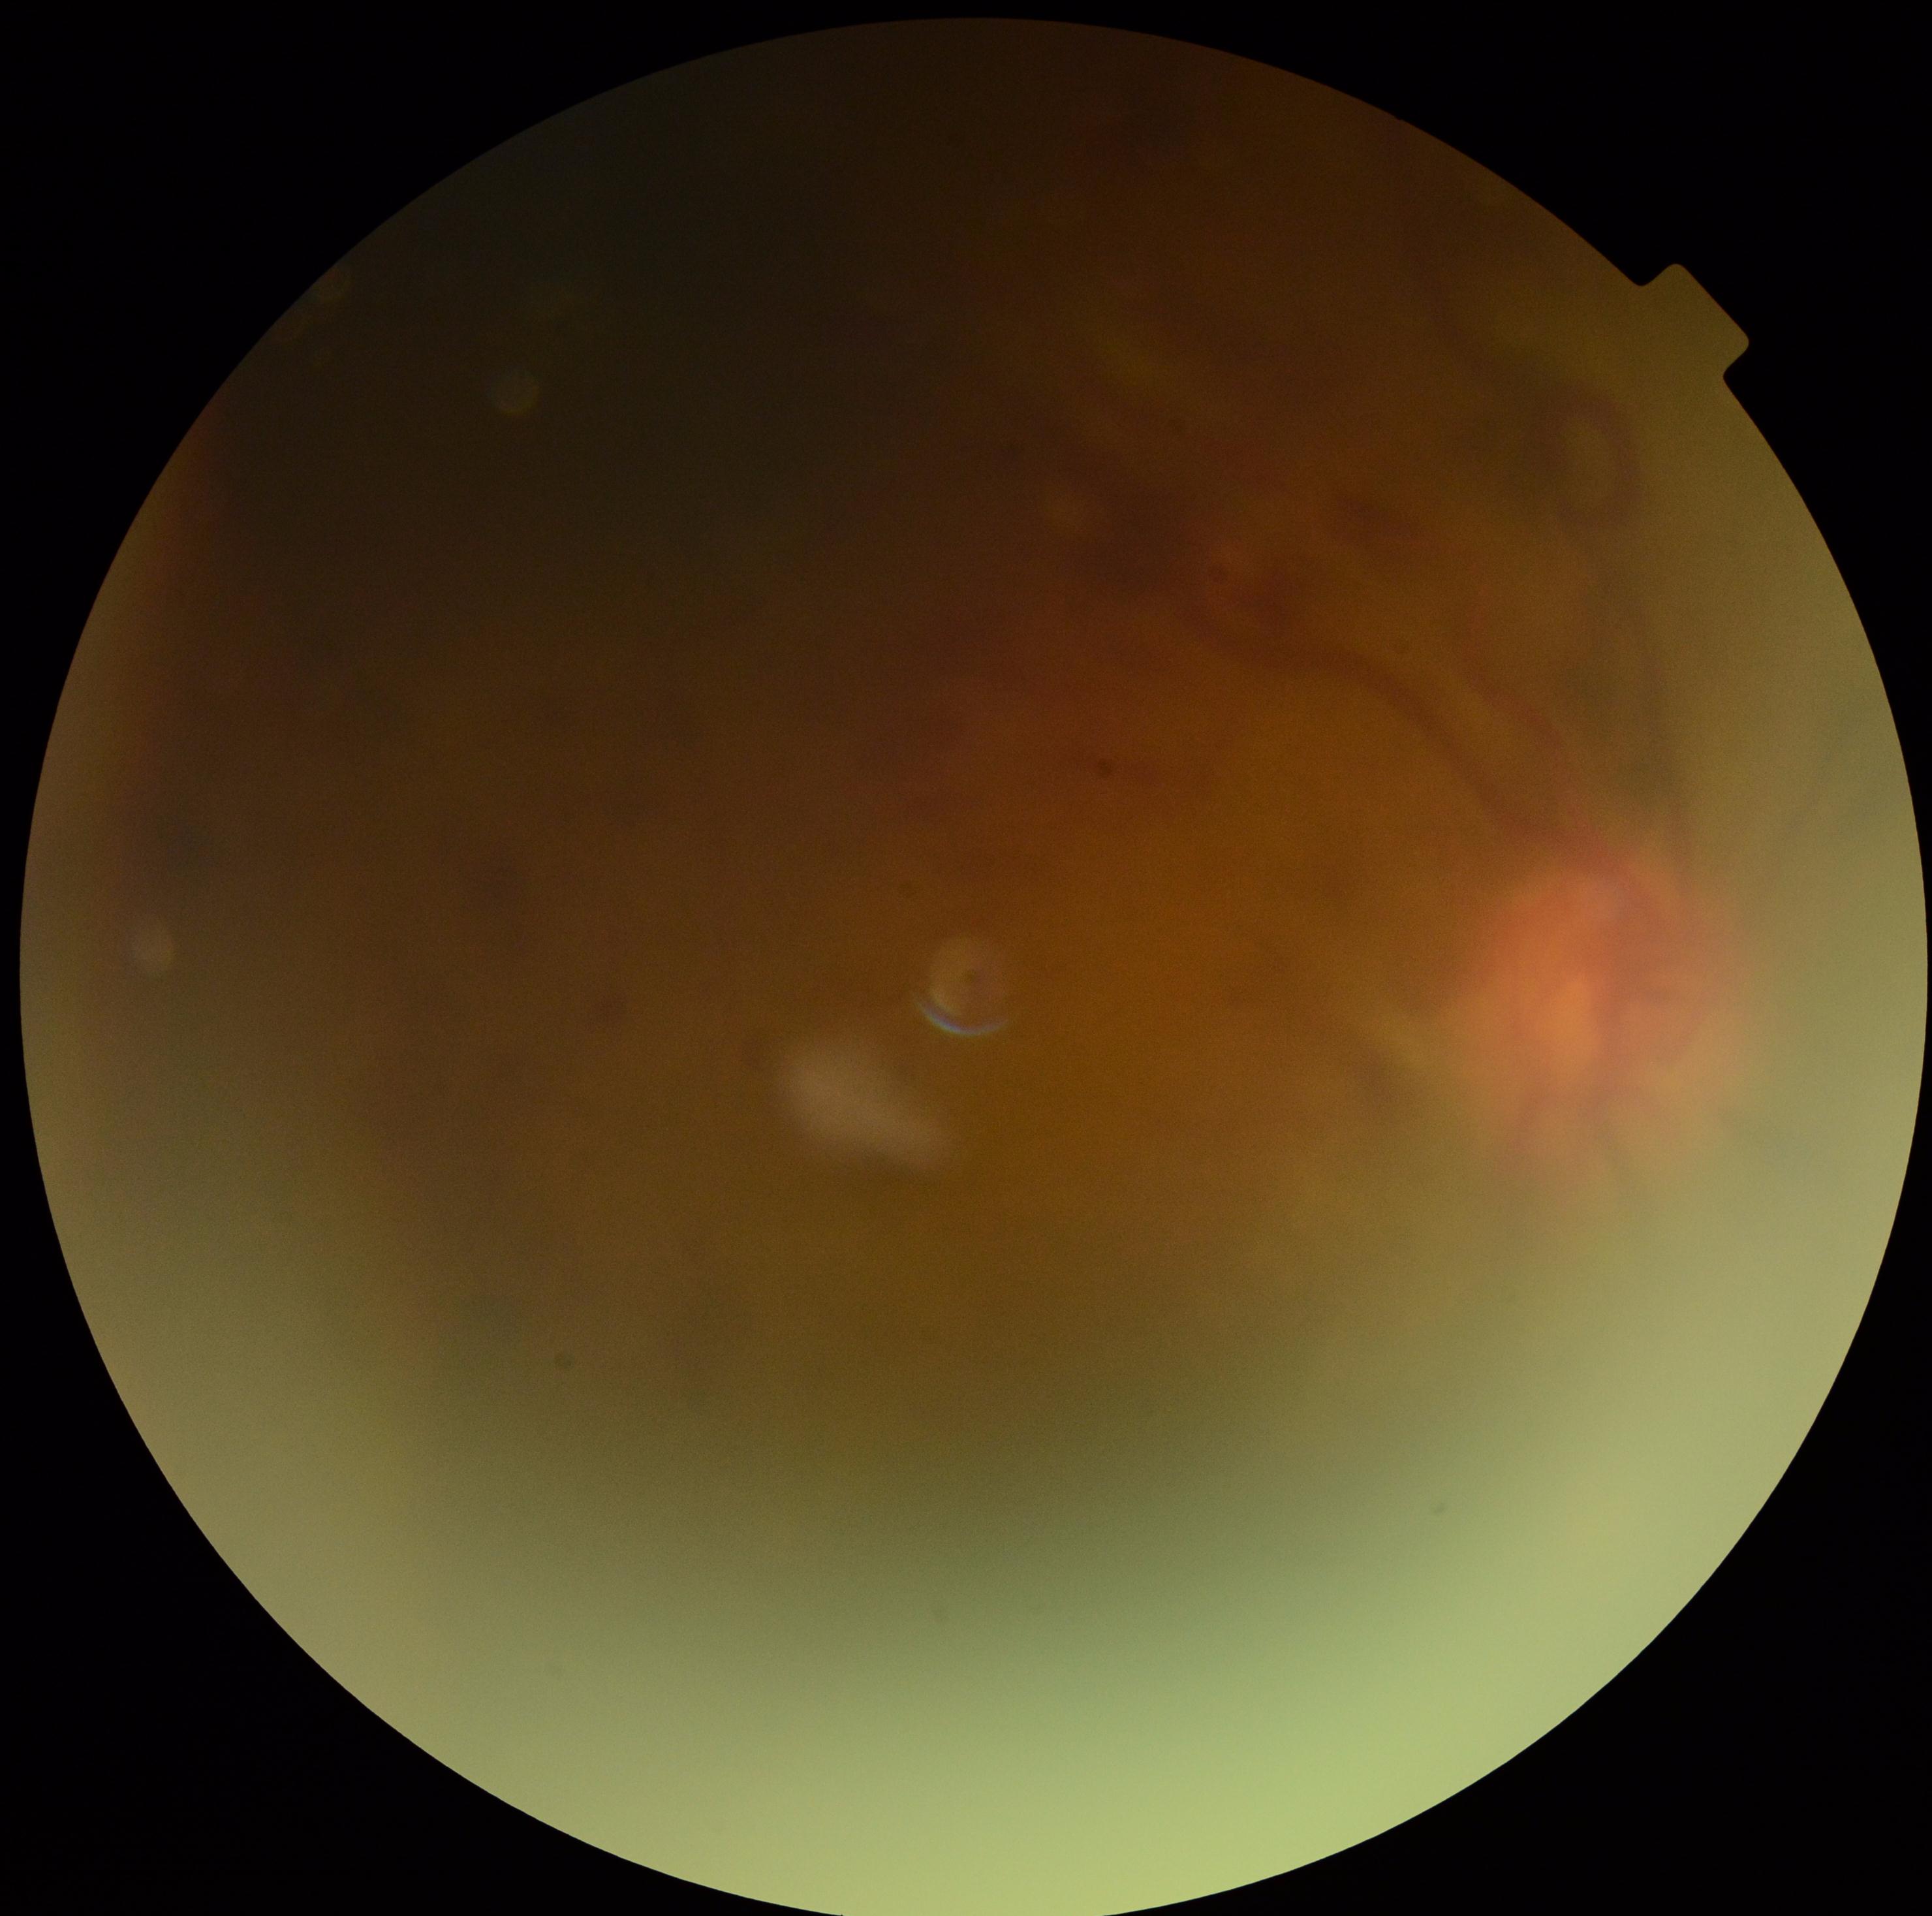 Diabetic retinopathy severity: grade 4 (PDR).